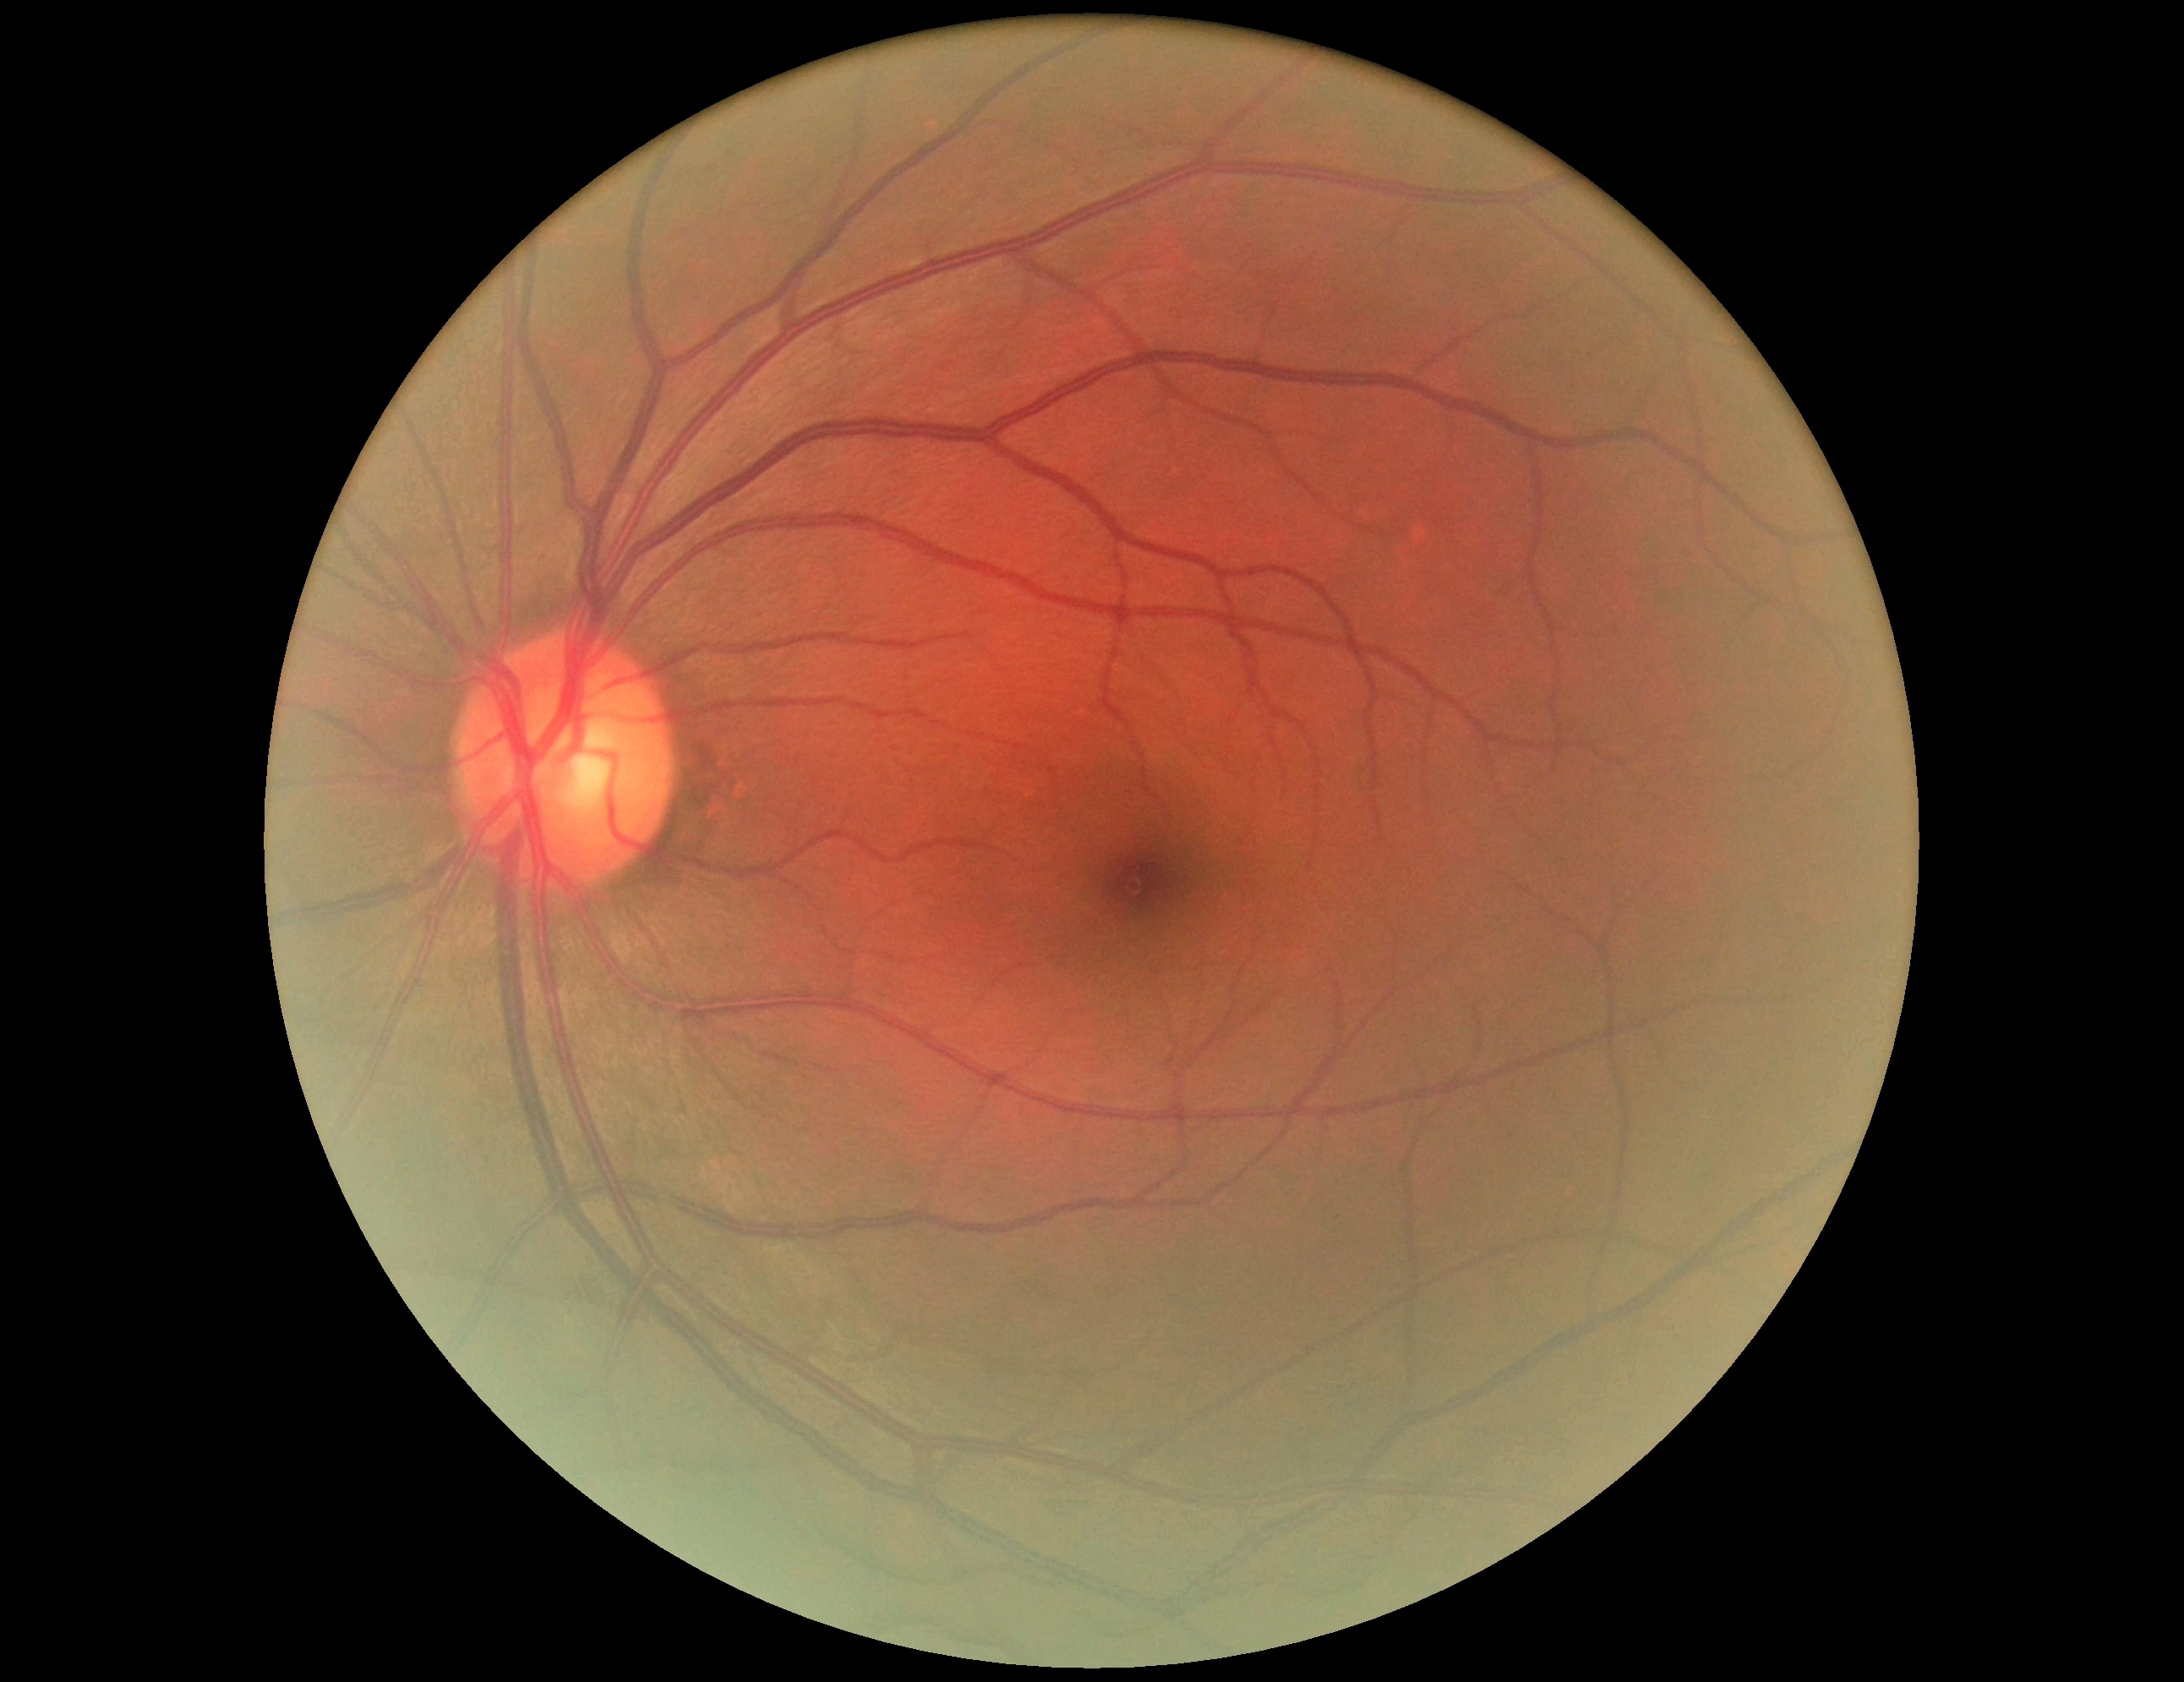
DR grade: 0/4 — no visible signs of diabetic retinopathy.